Pediatric retinal photograph (wide-field) · 1440 x 1080 pixels.
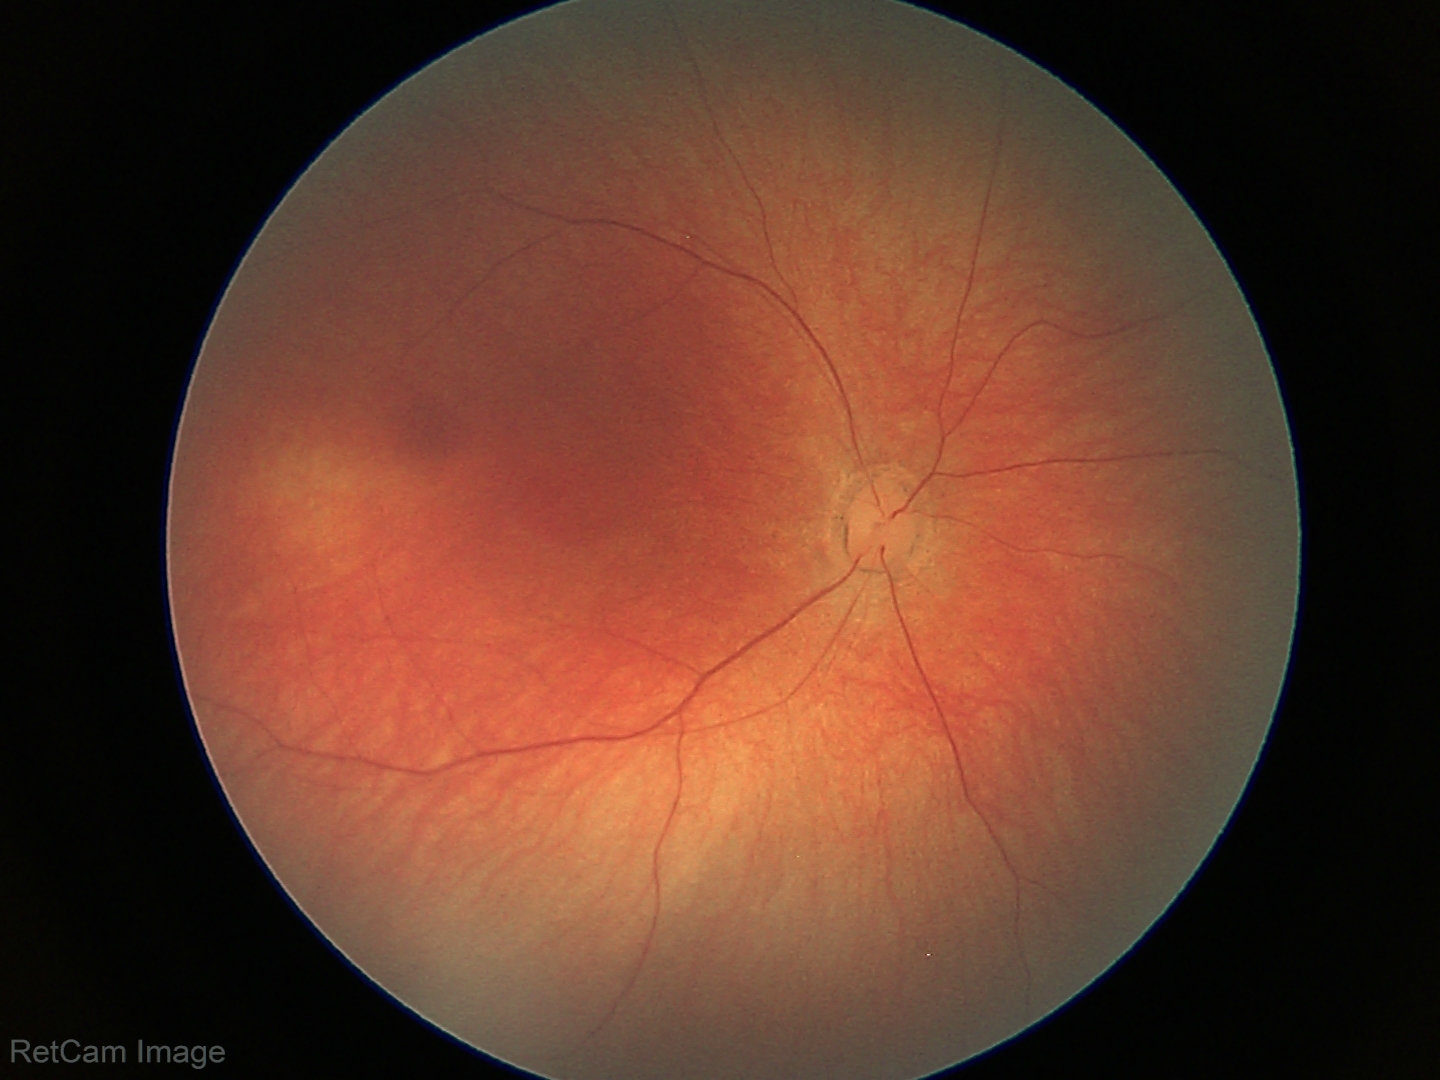

Screening diagnosis: no abnormalities.